FOV: 45 degrees — 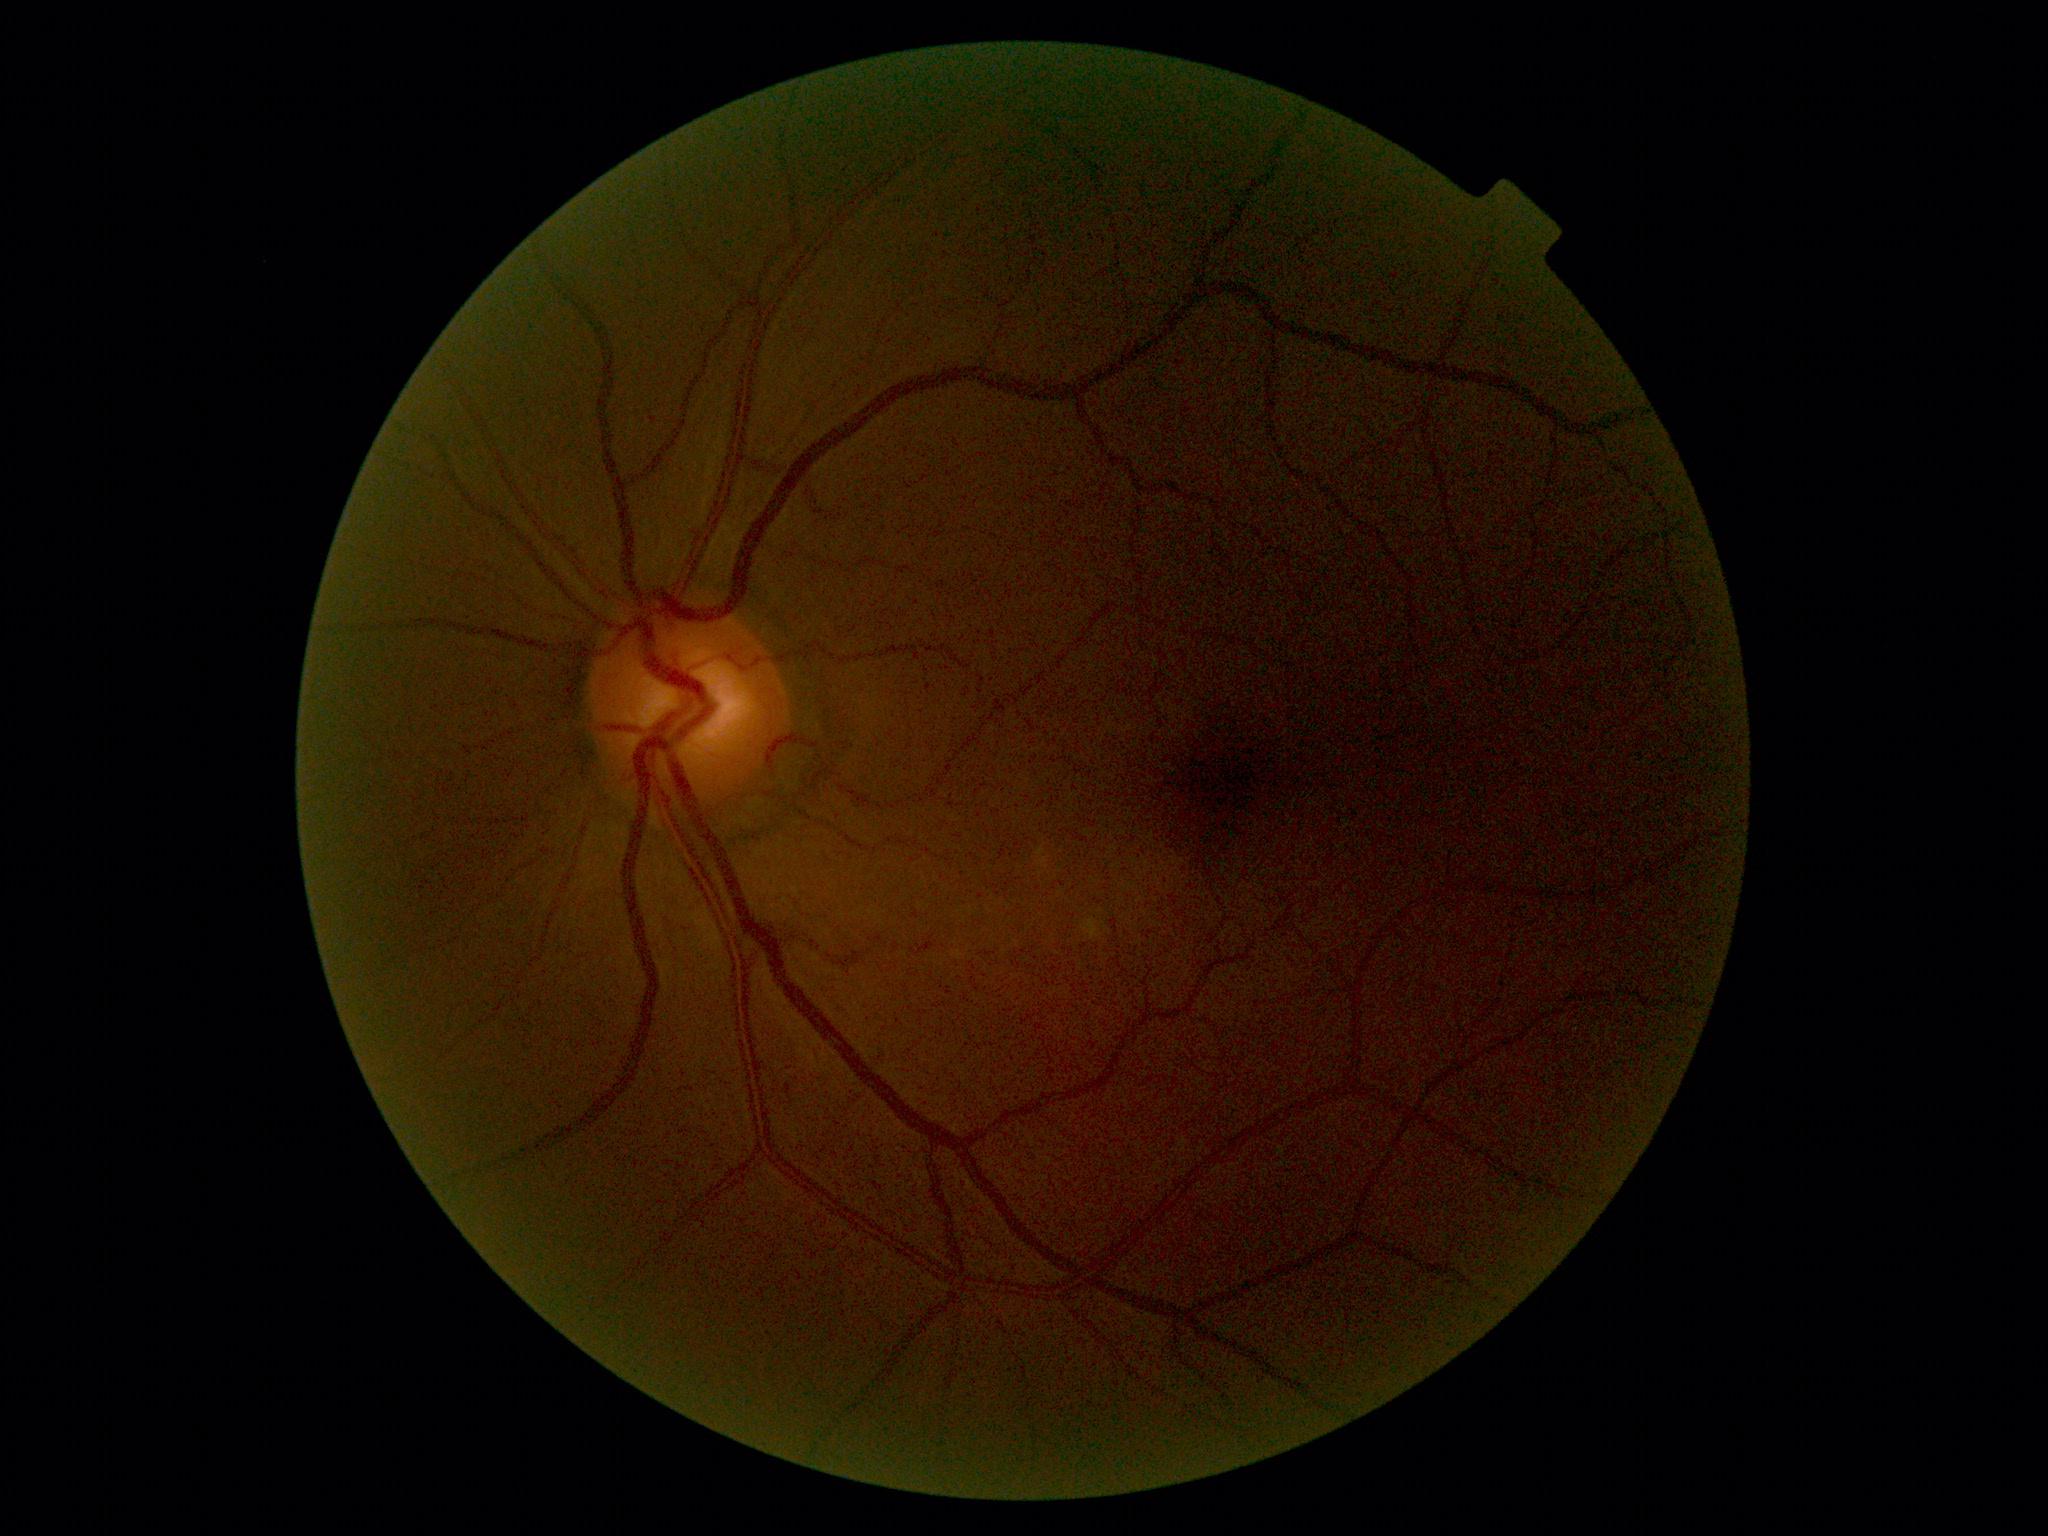

retinopathy grade: 0 (no apparent retinopathy).